45° FOV.
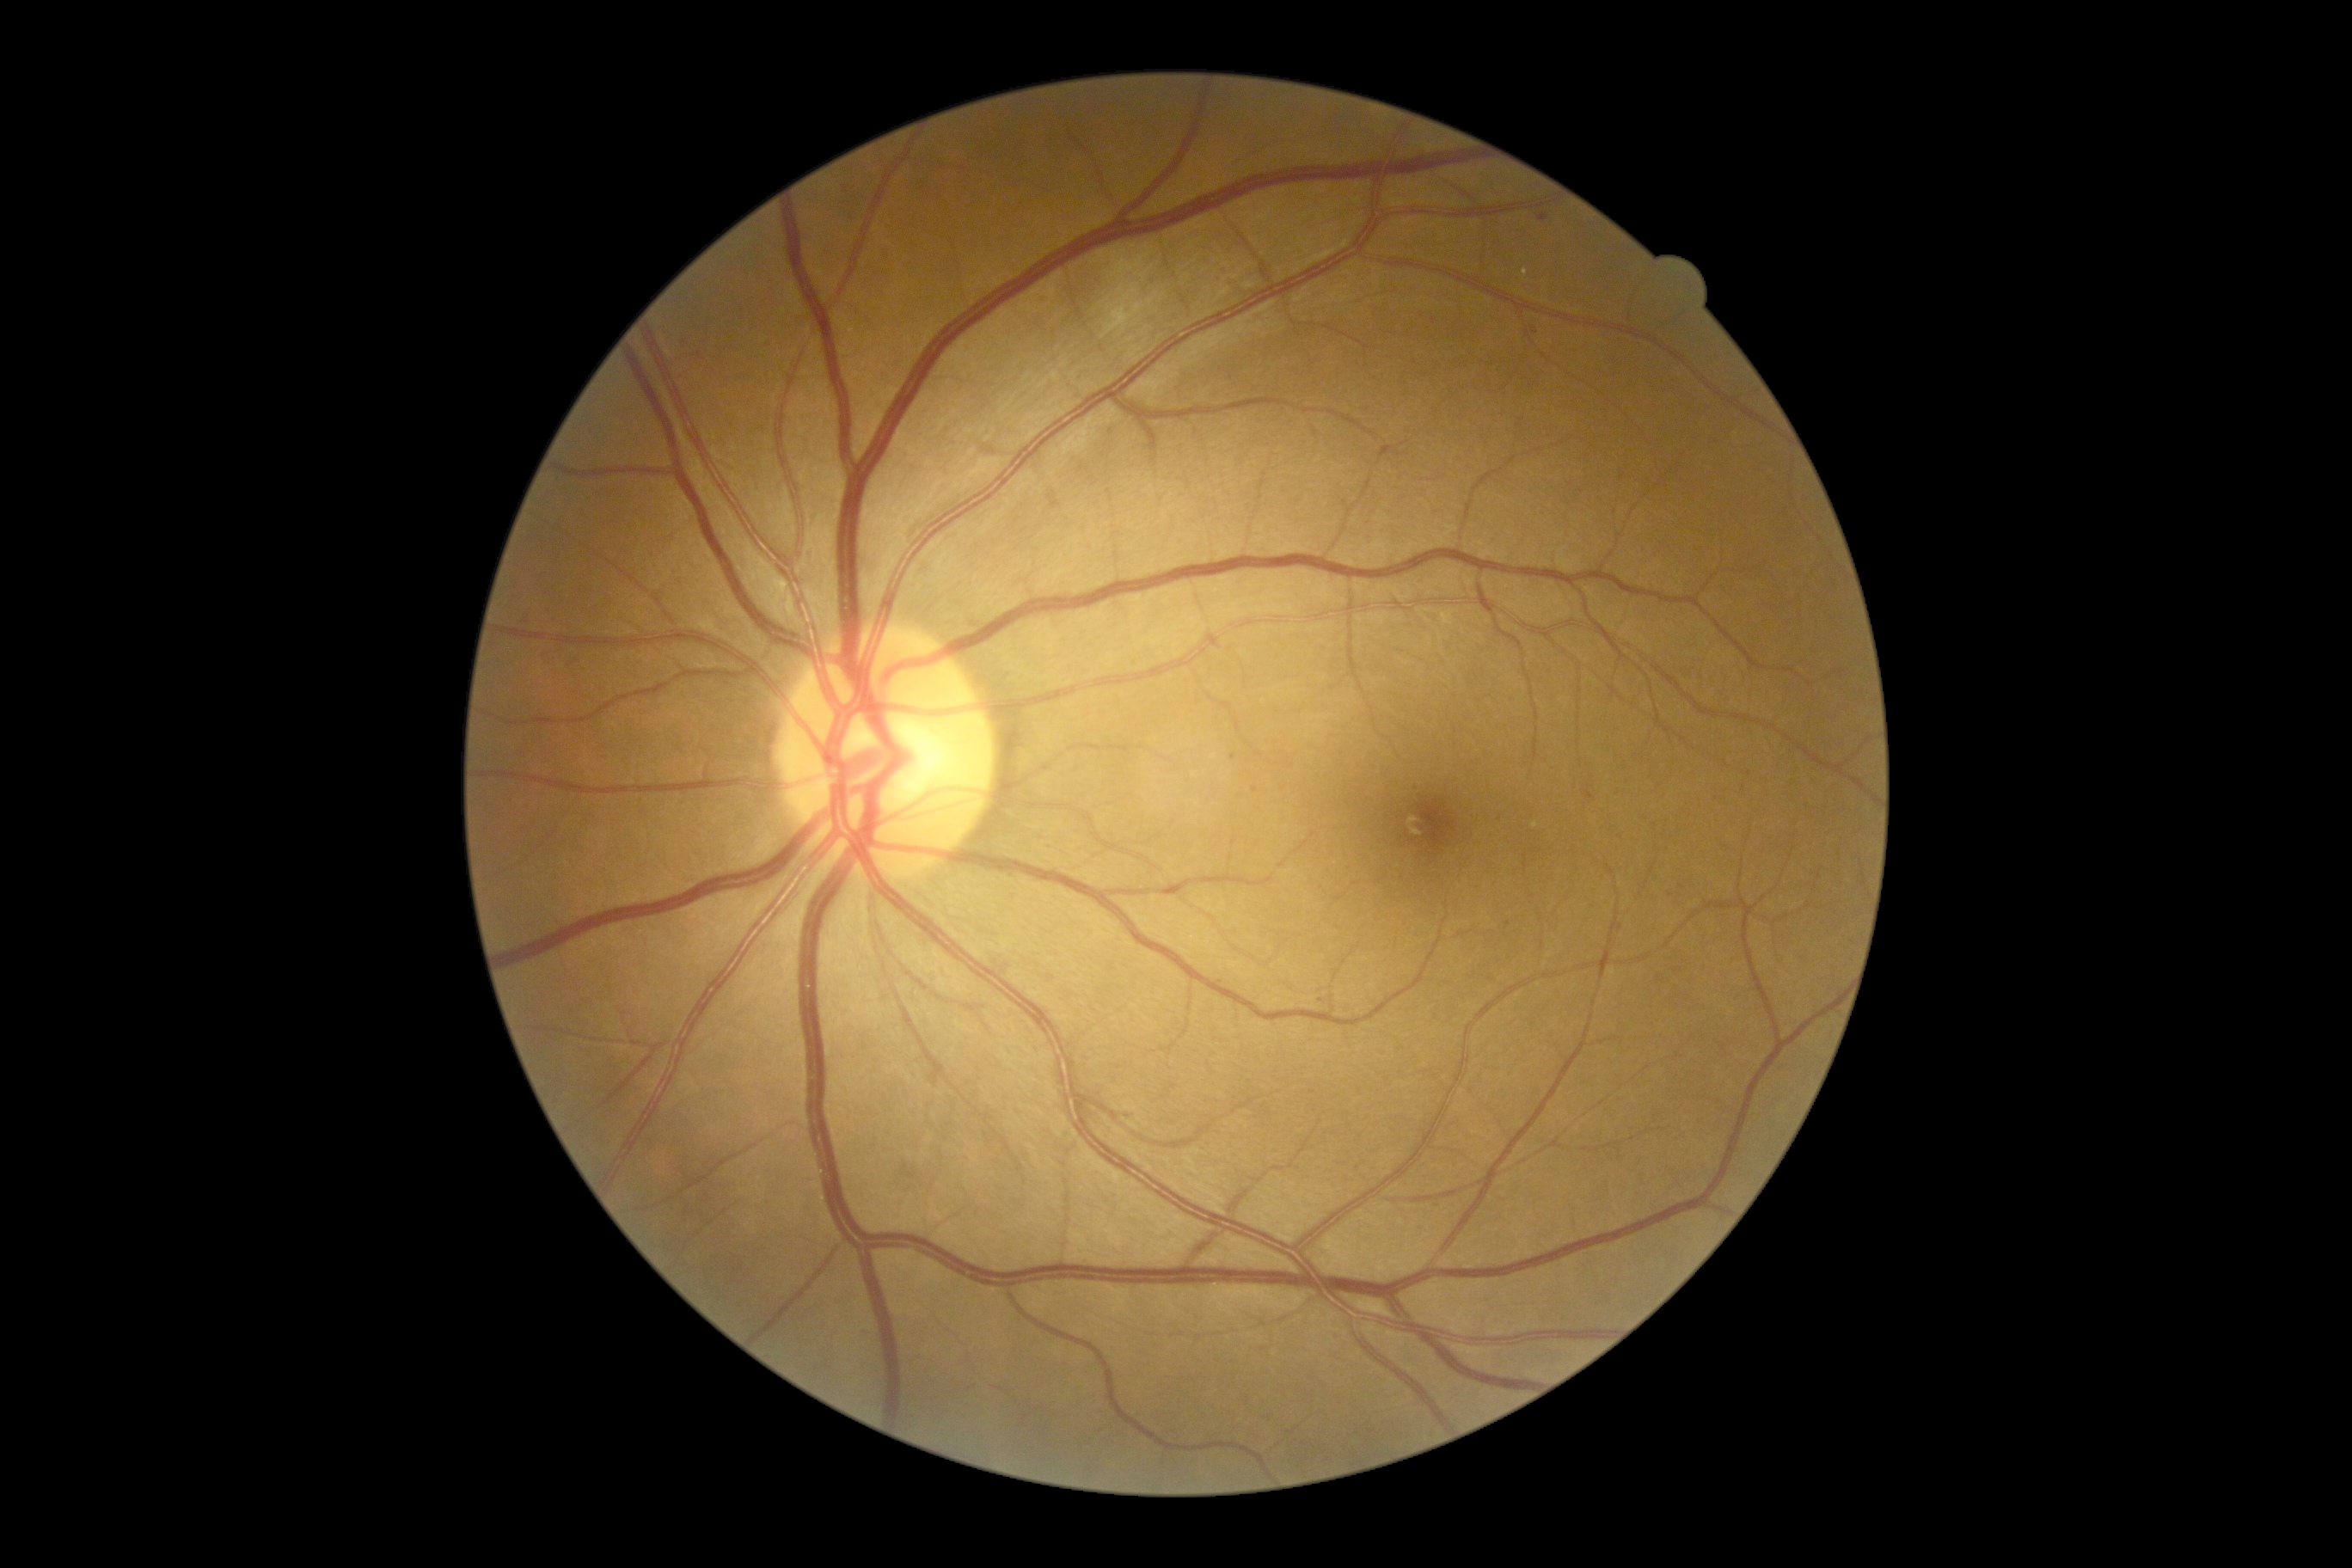
diabetic retinopathy severity = grade 1 (mild NPDR) — presence of microaneurysms only; DR class = non-proliferative diabetic retinopathy.